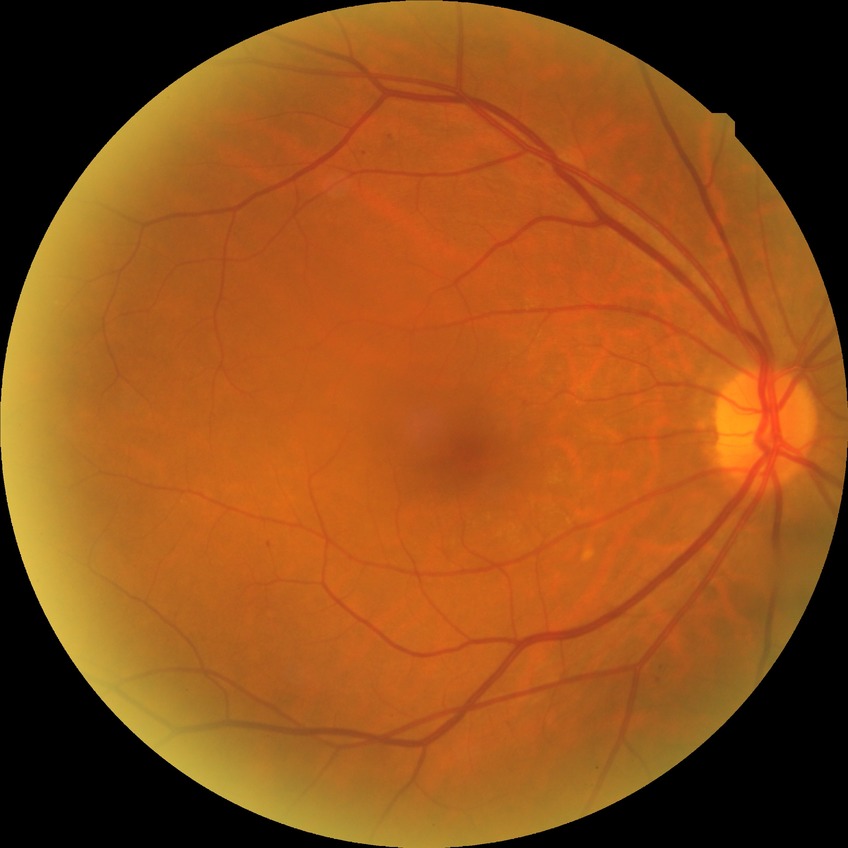

Retinopathy grade is simple diabetic retinopathy.